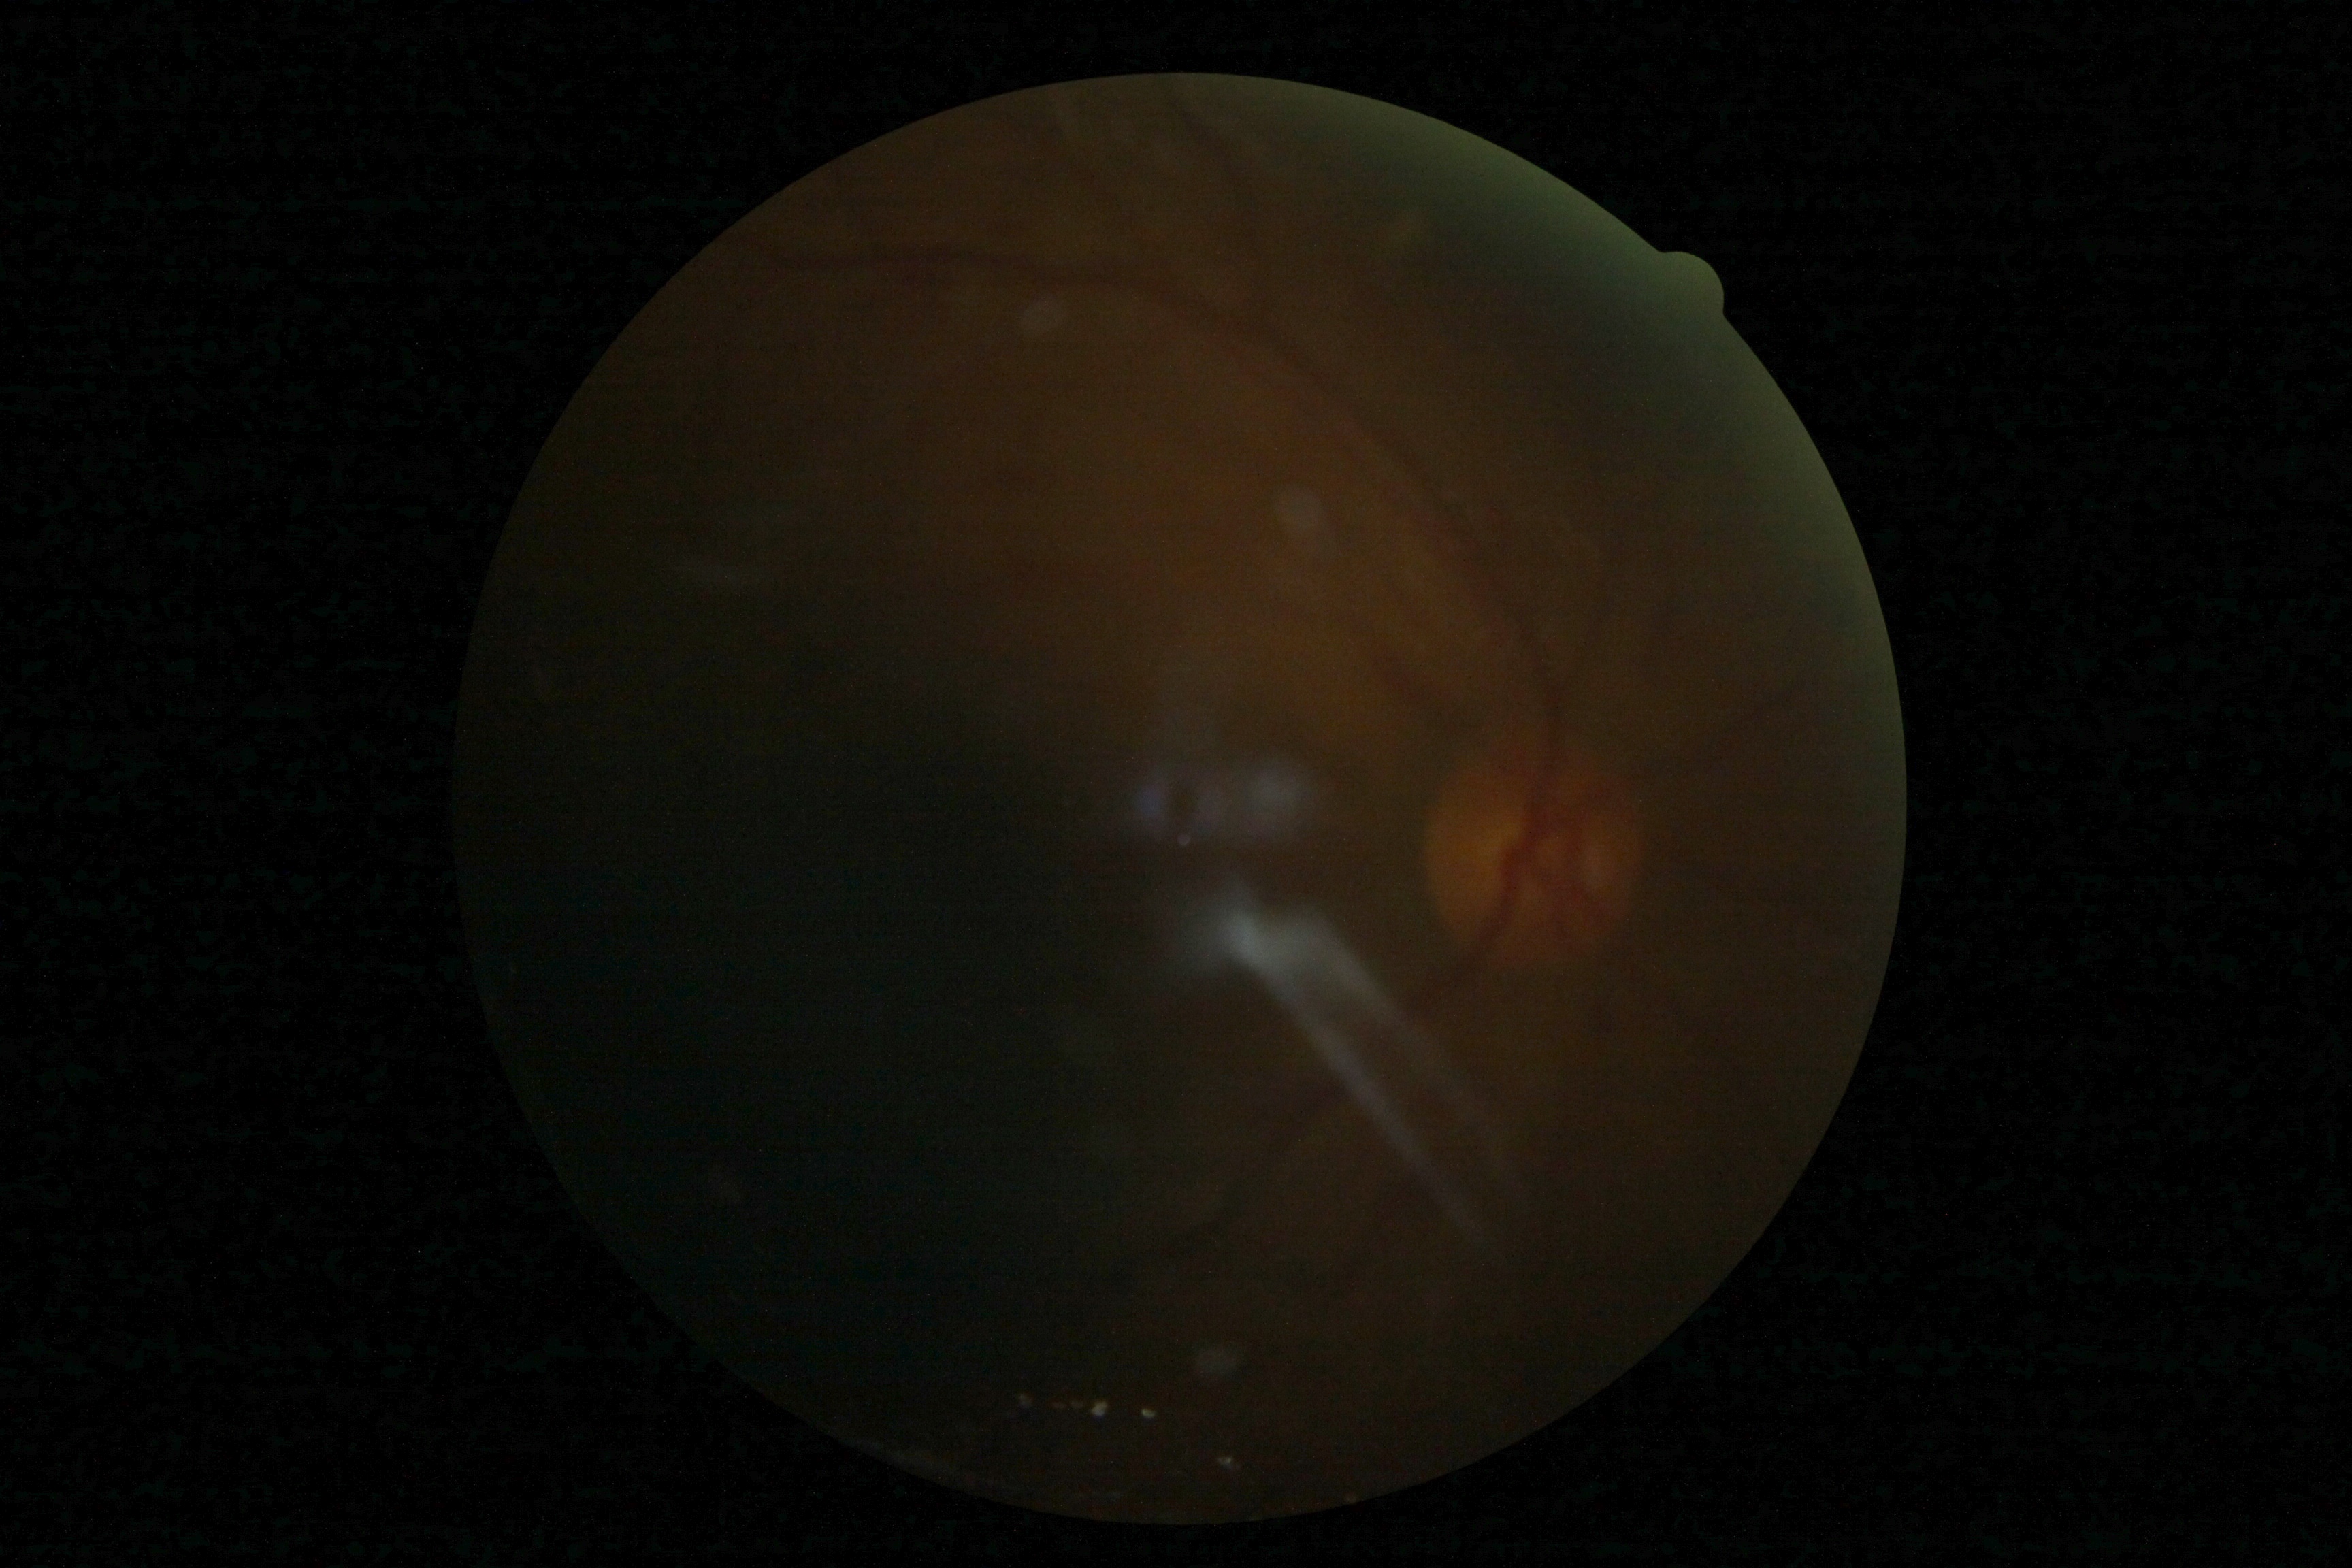 The image cannot be graded for diabetic retinopathy.
DR: ungradable due to poor image quality.